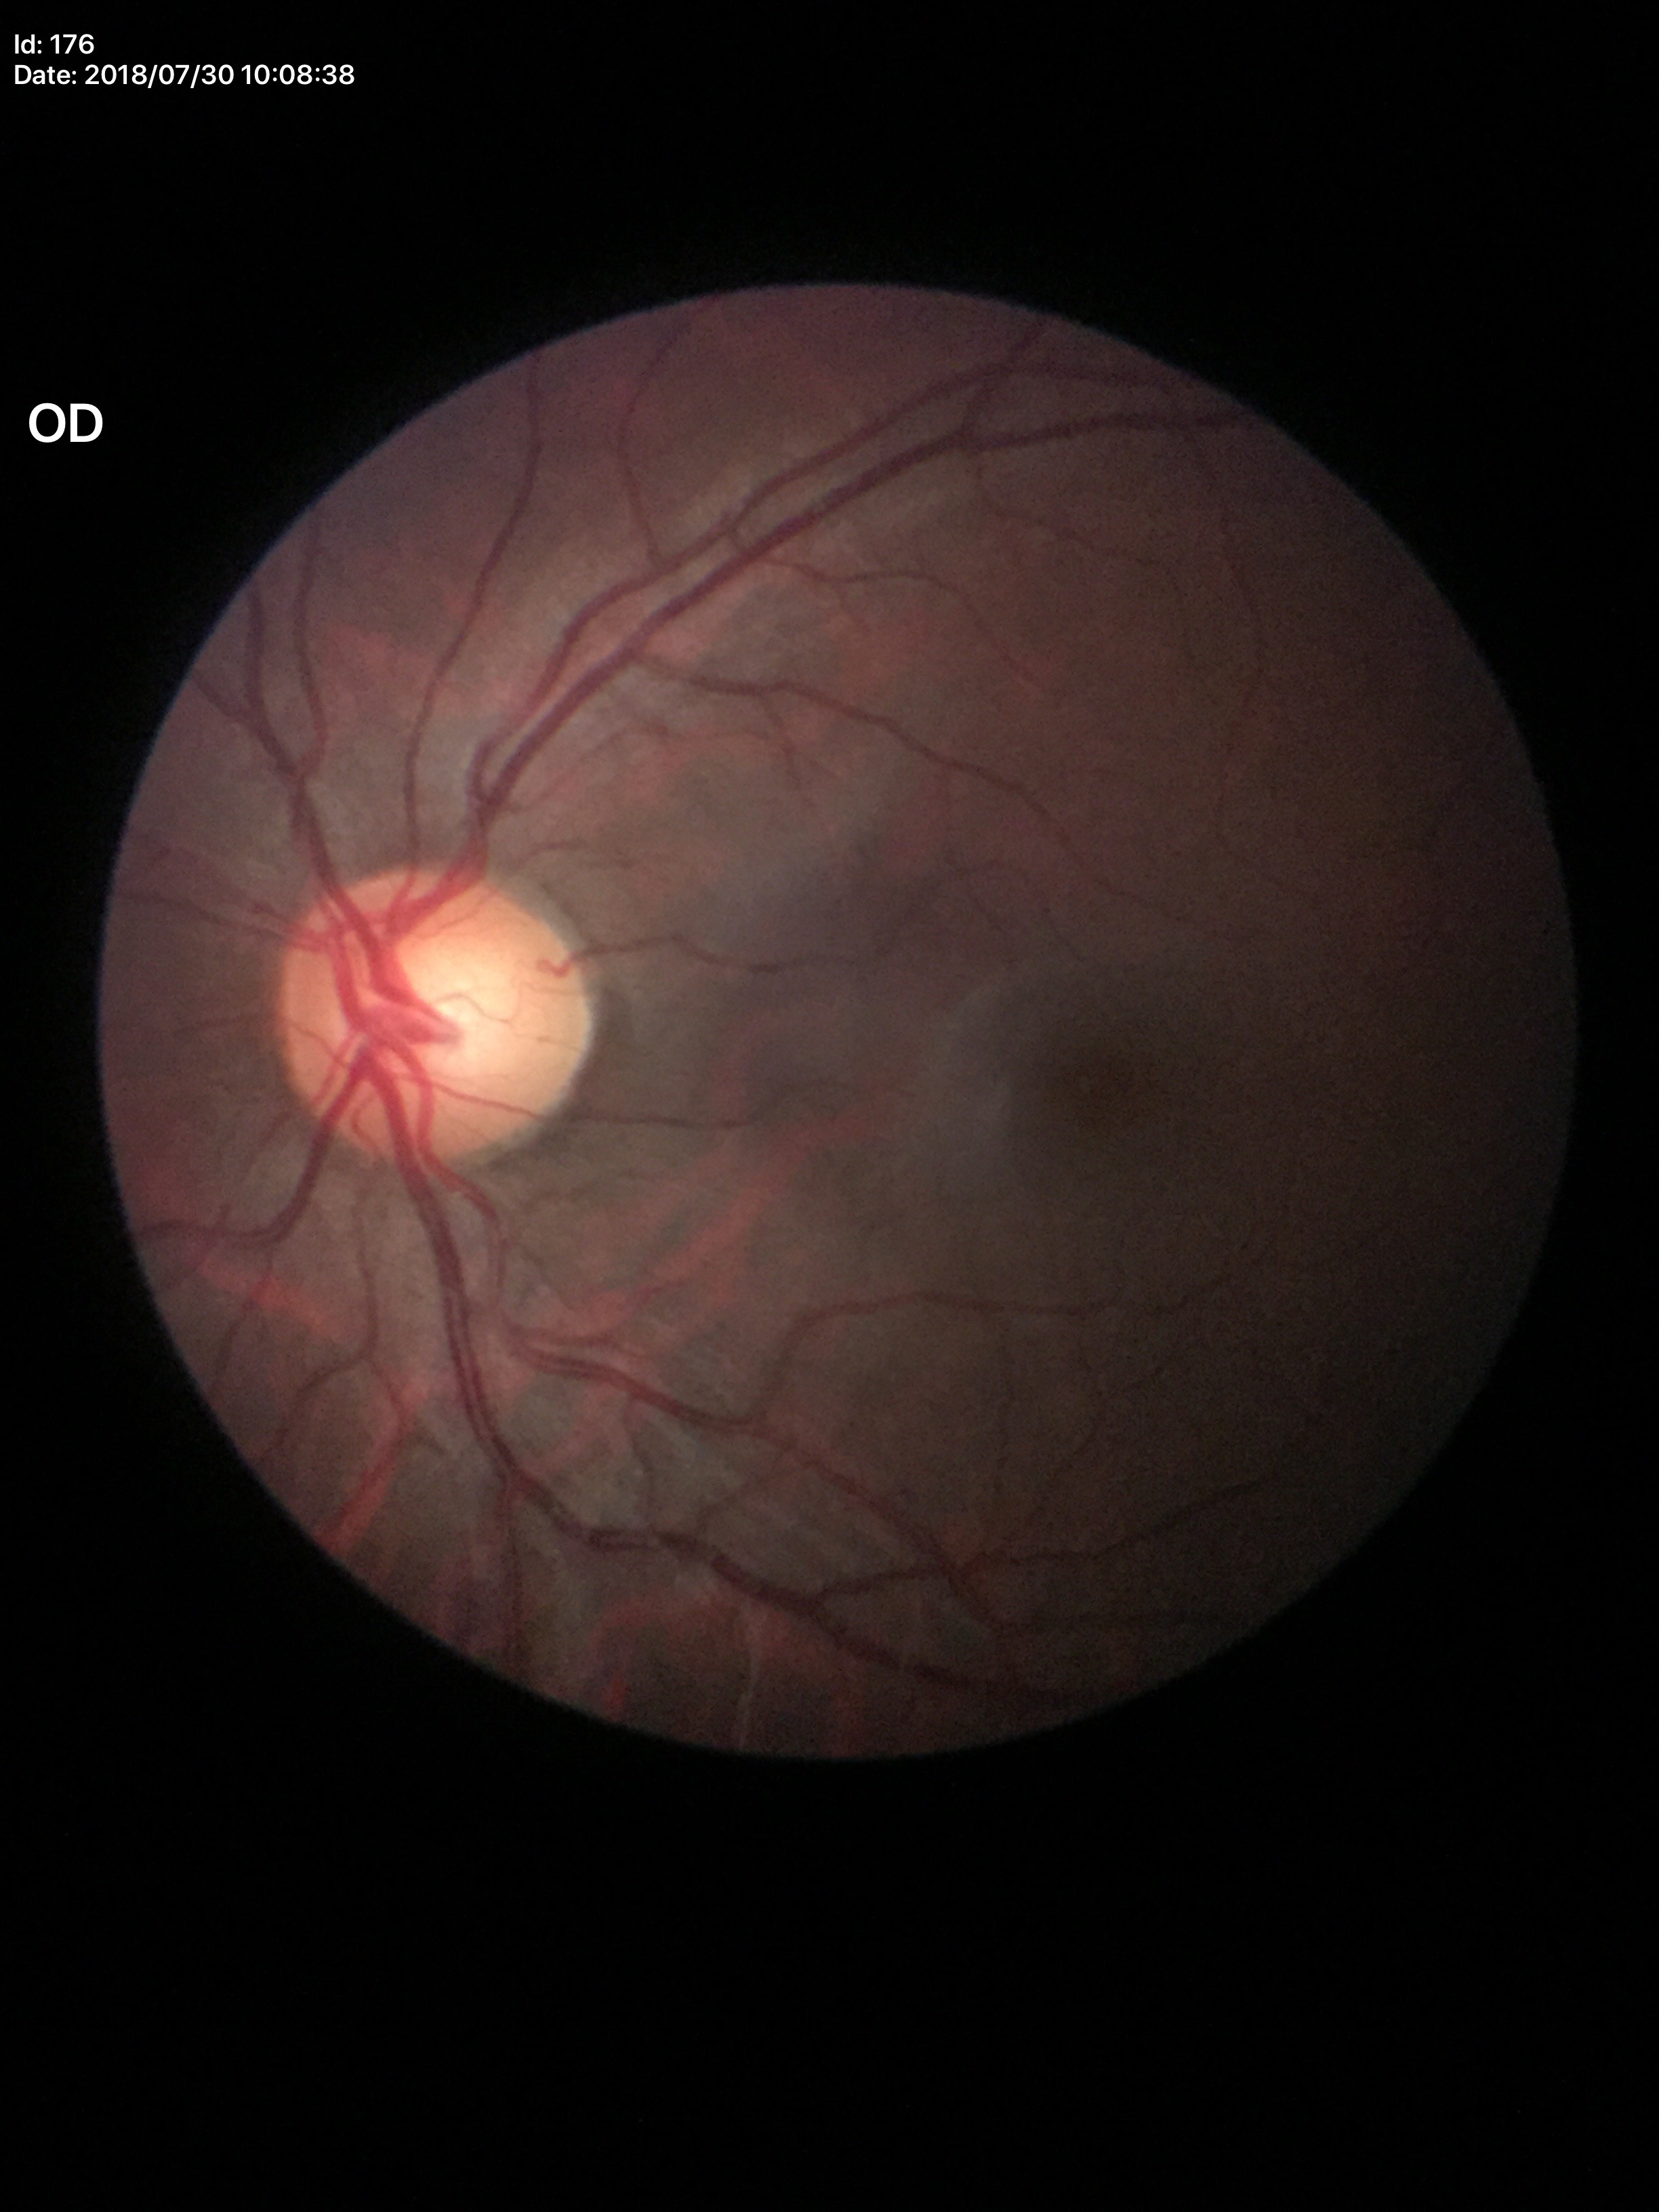 Negative for glaucoma suspicion. Vertical cup-to-disc ratio of 0.58.